Wide-field fundus image from infant ROP screening. 1240 by 1240 pixels
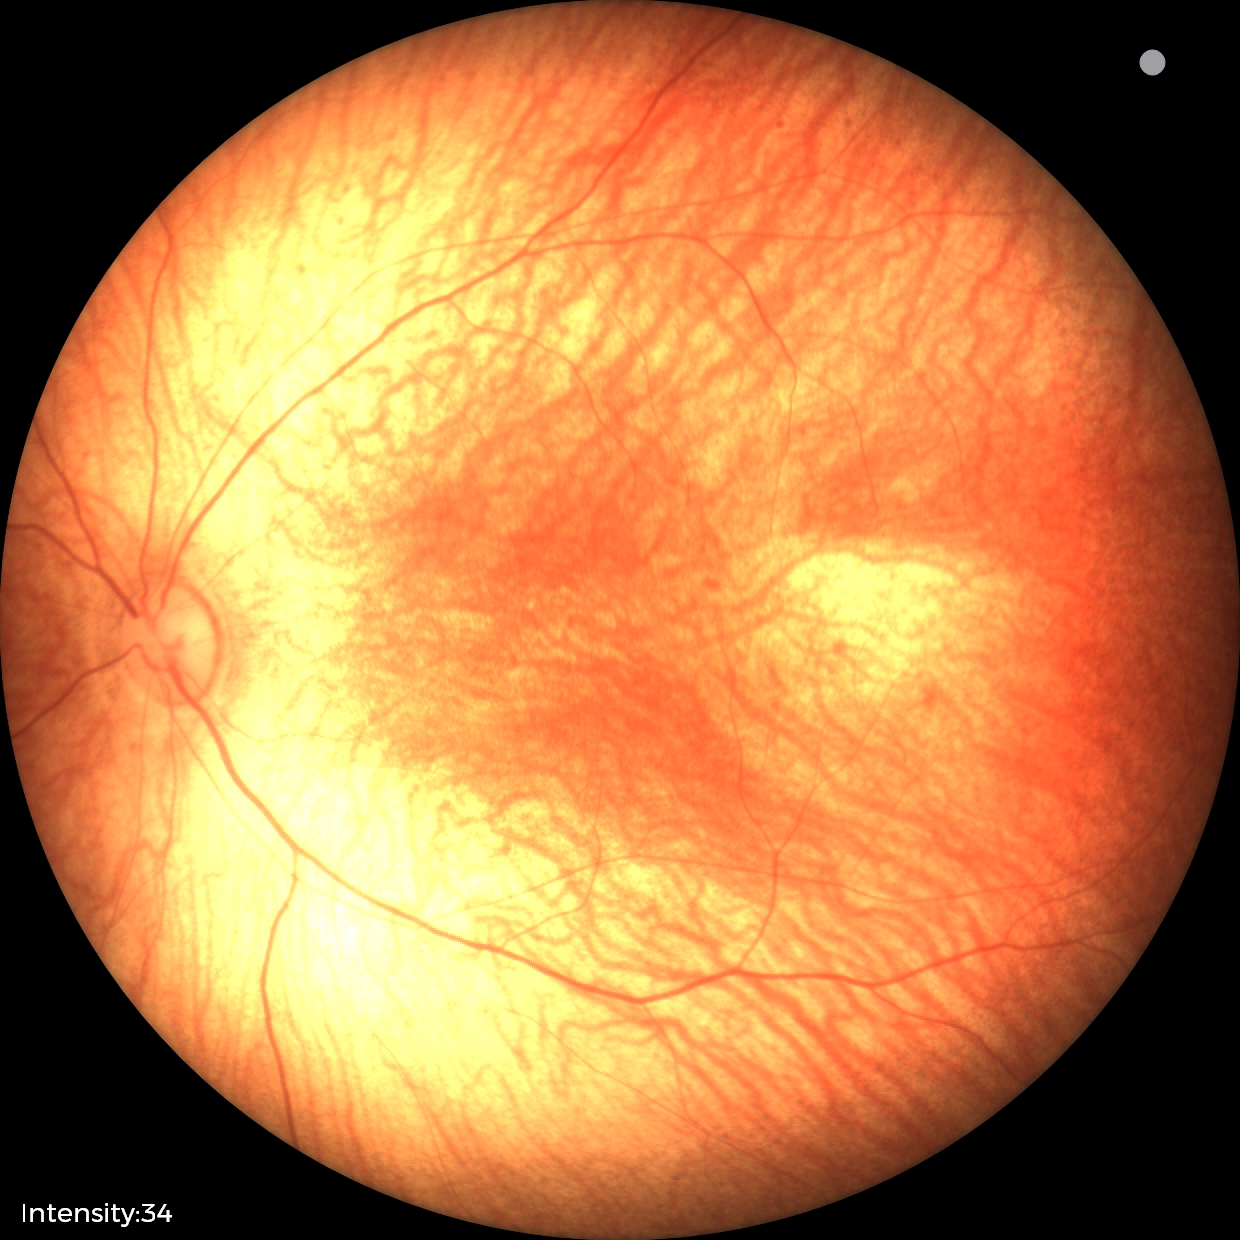 Screening examination diagnosed as physiological.